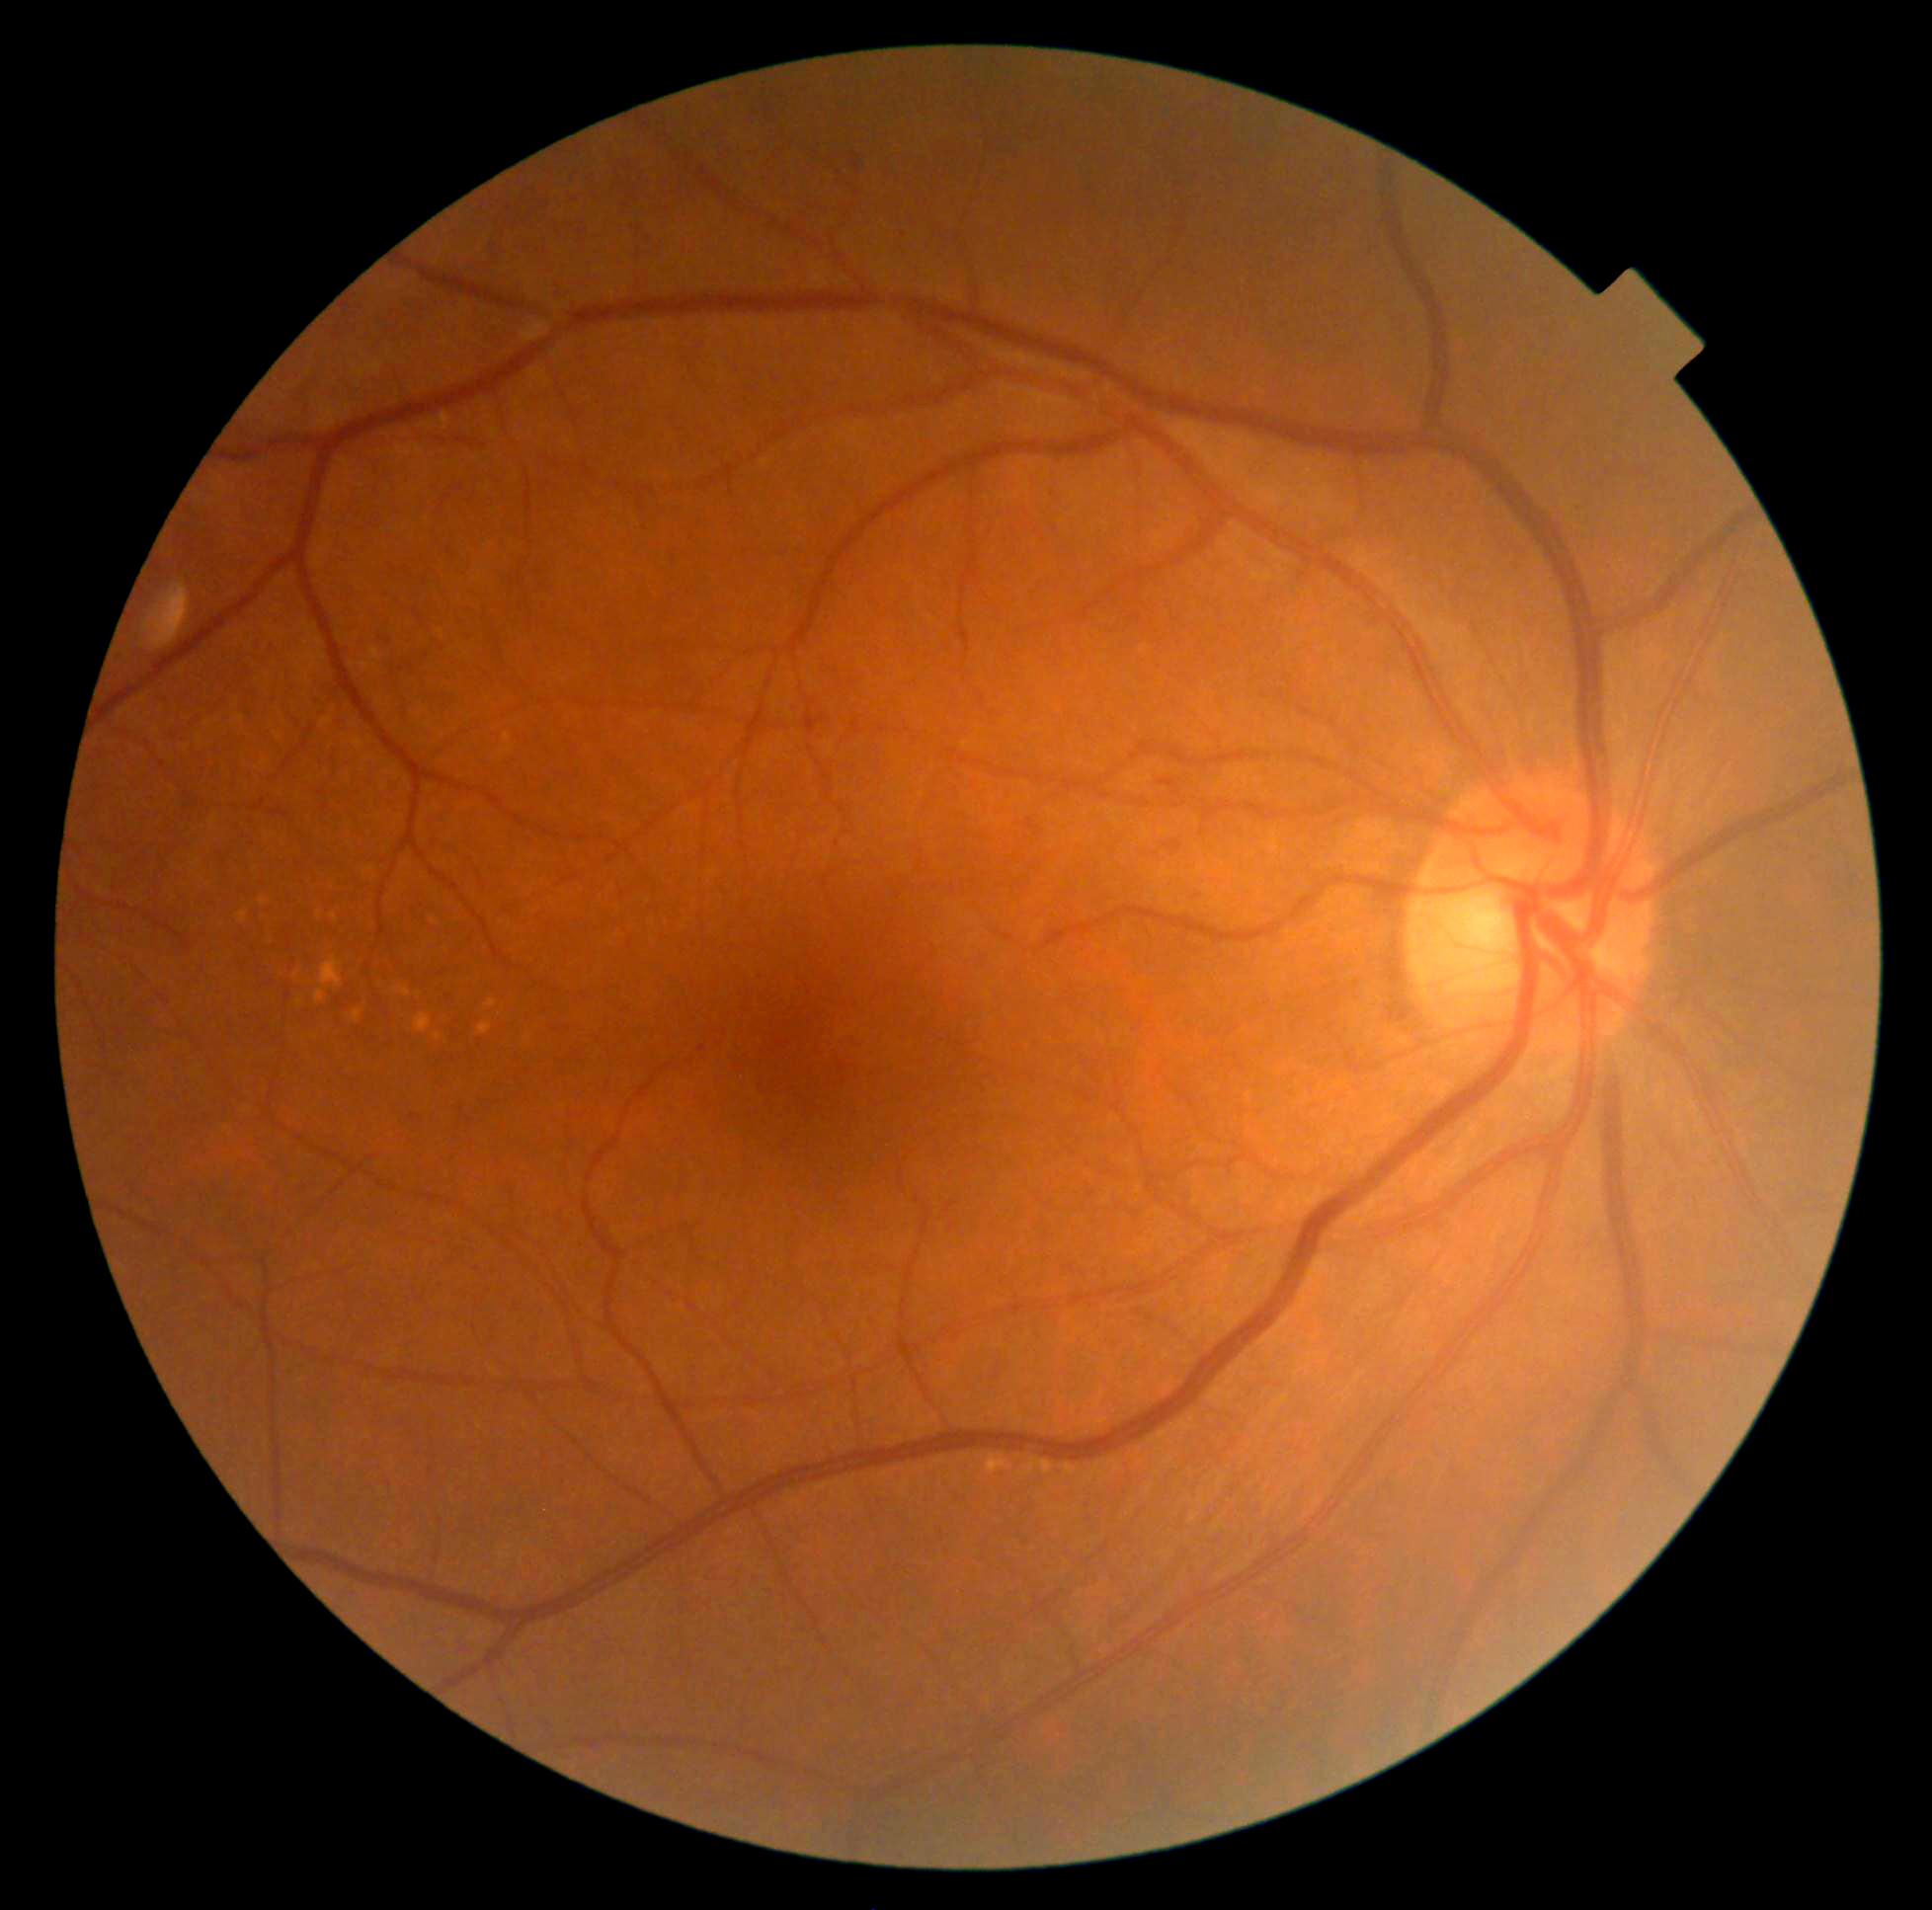 diabetic retinopathy grade = 0 (no apparent retinopathy) — no visible signs of diabetic retinopathy